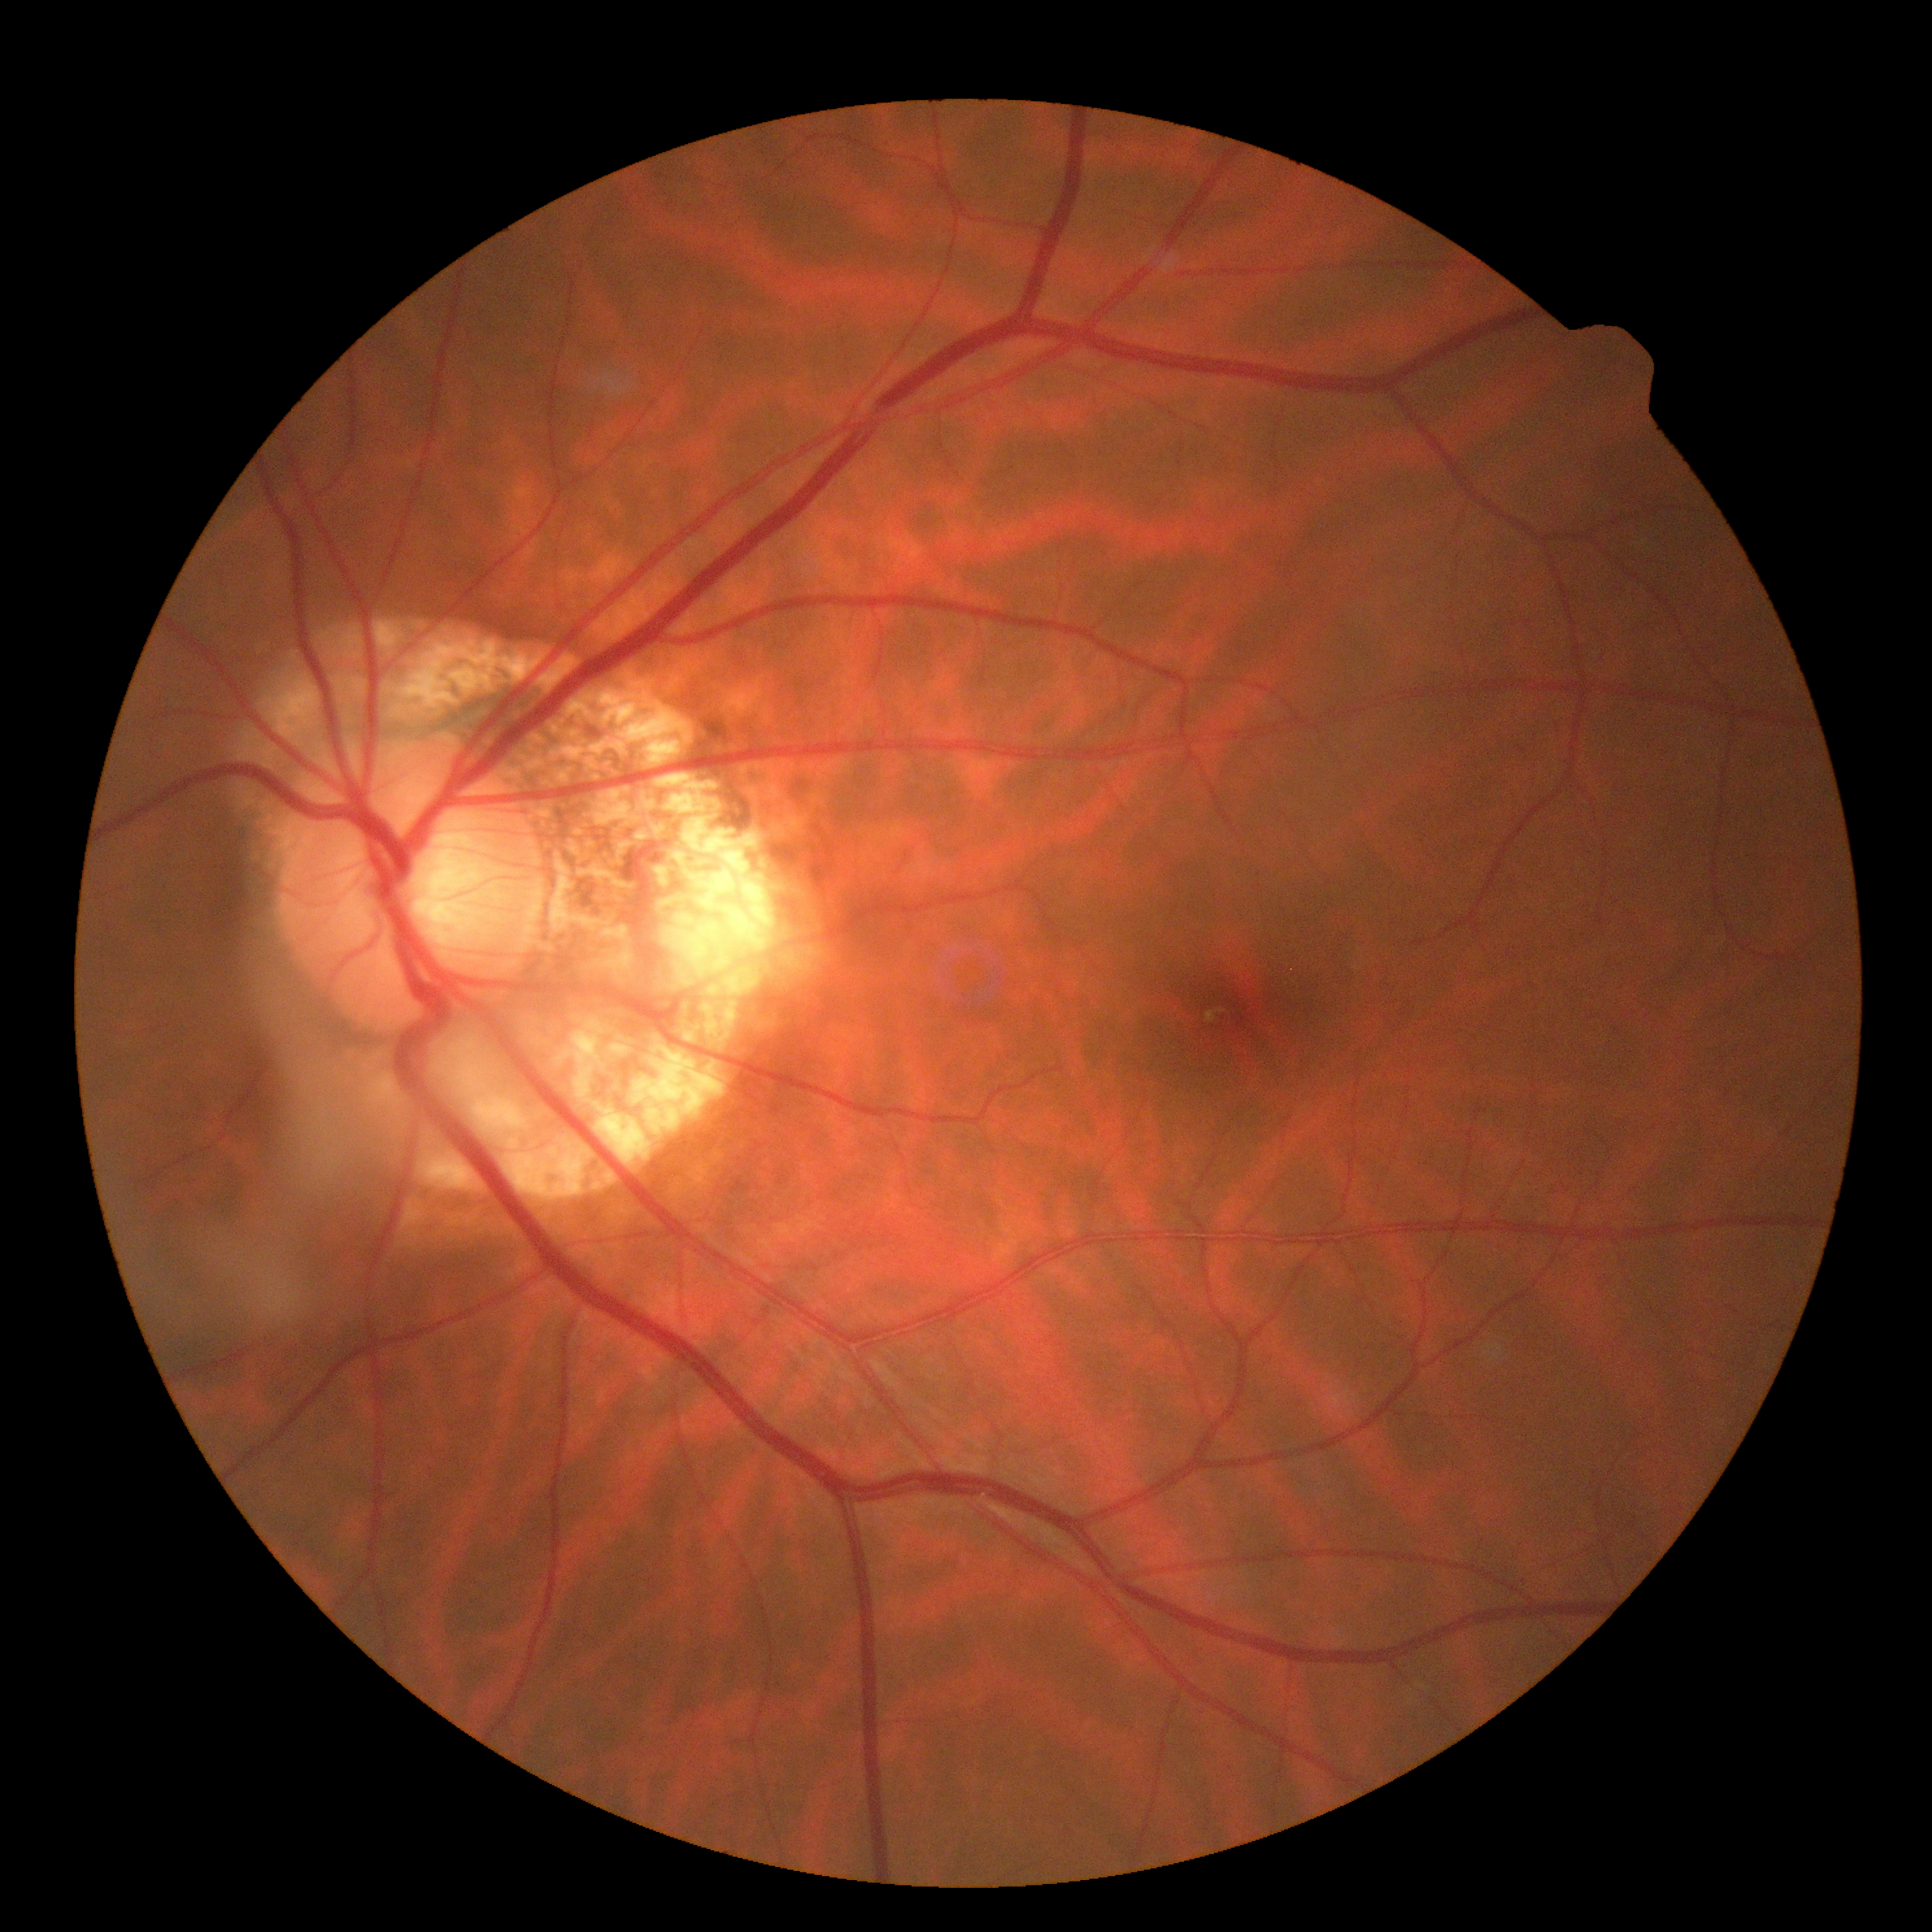
Retinopathy grade is 0. No signs of diabetic retinopathy.